45° field of view
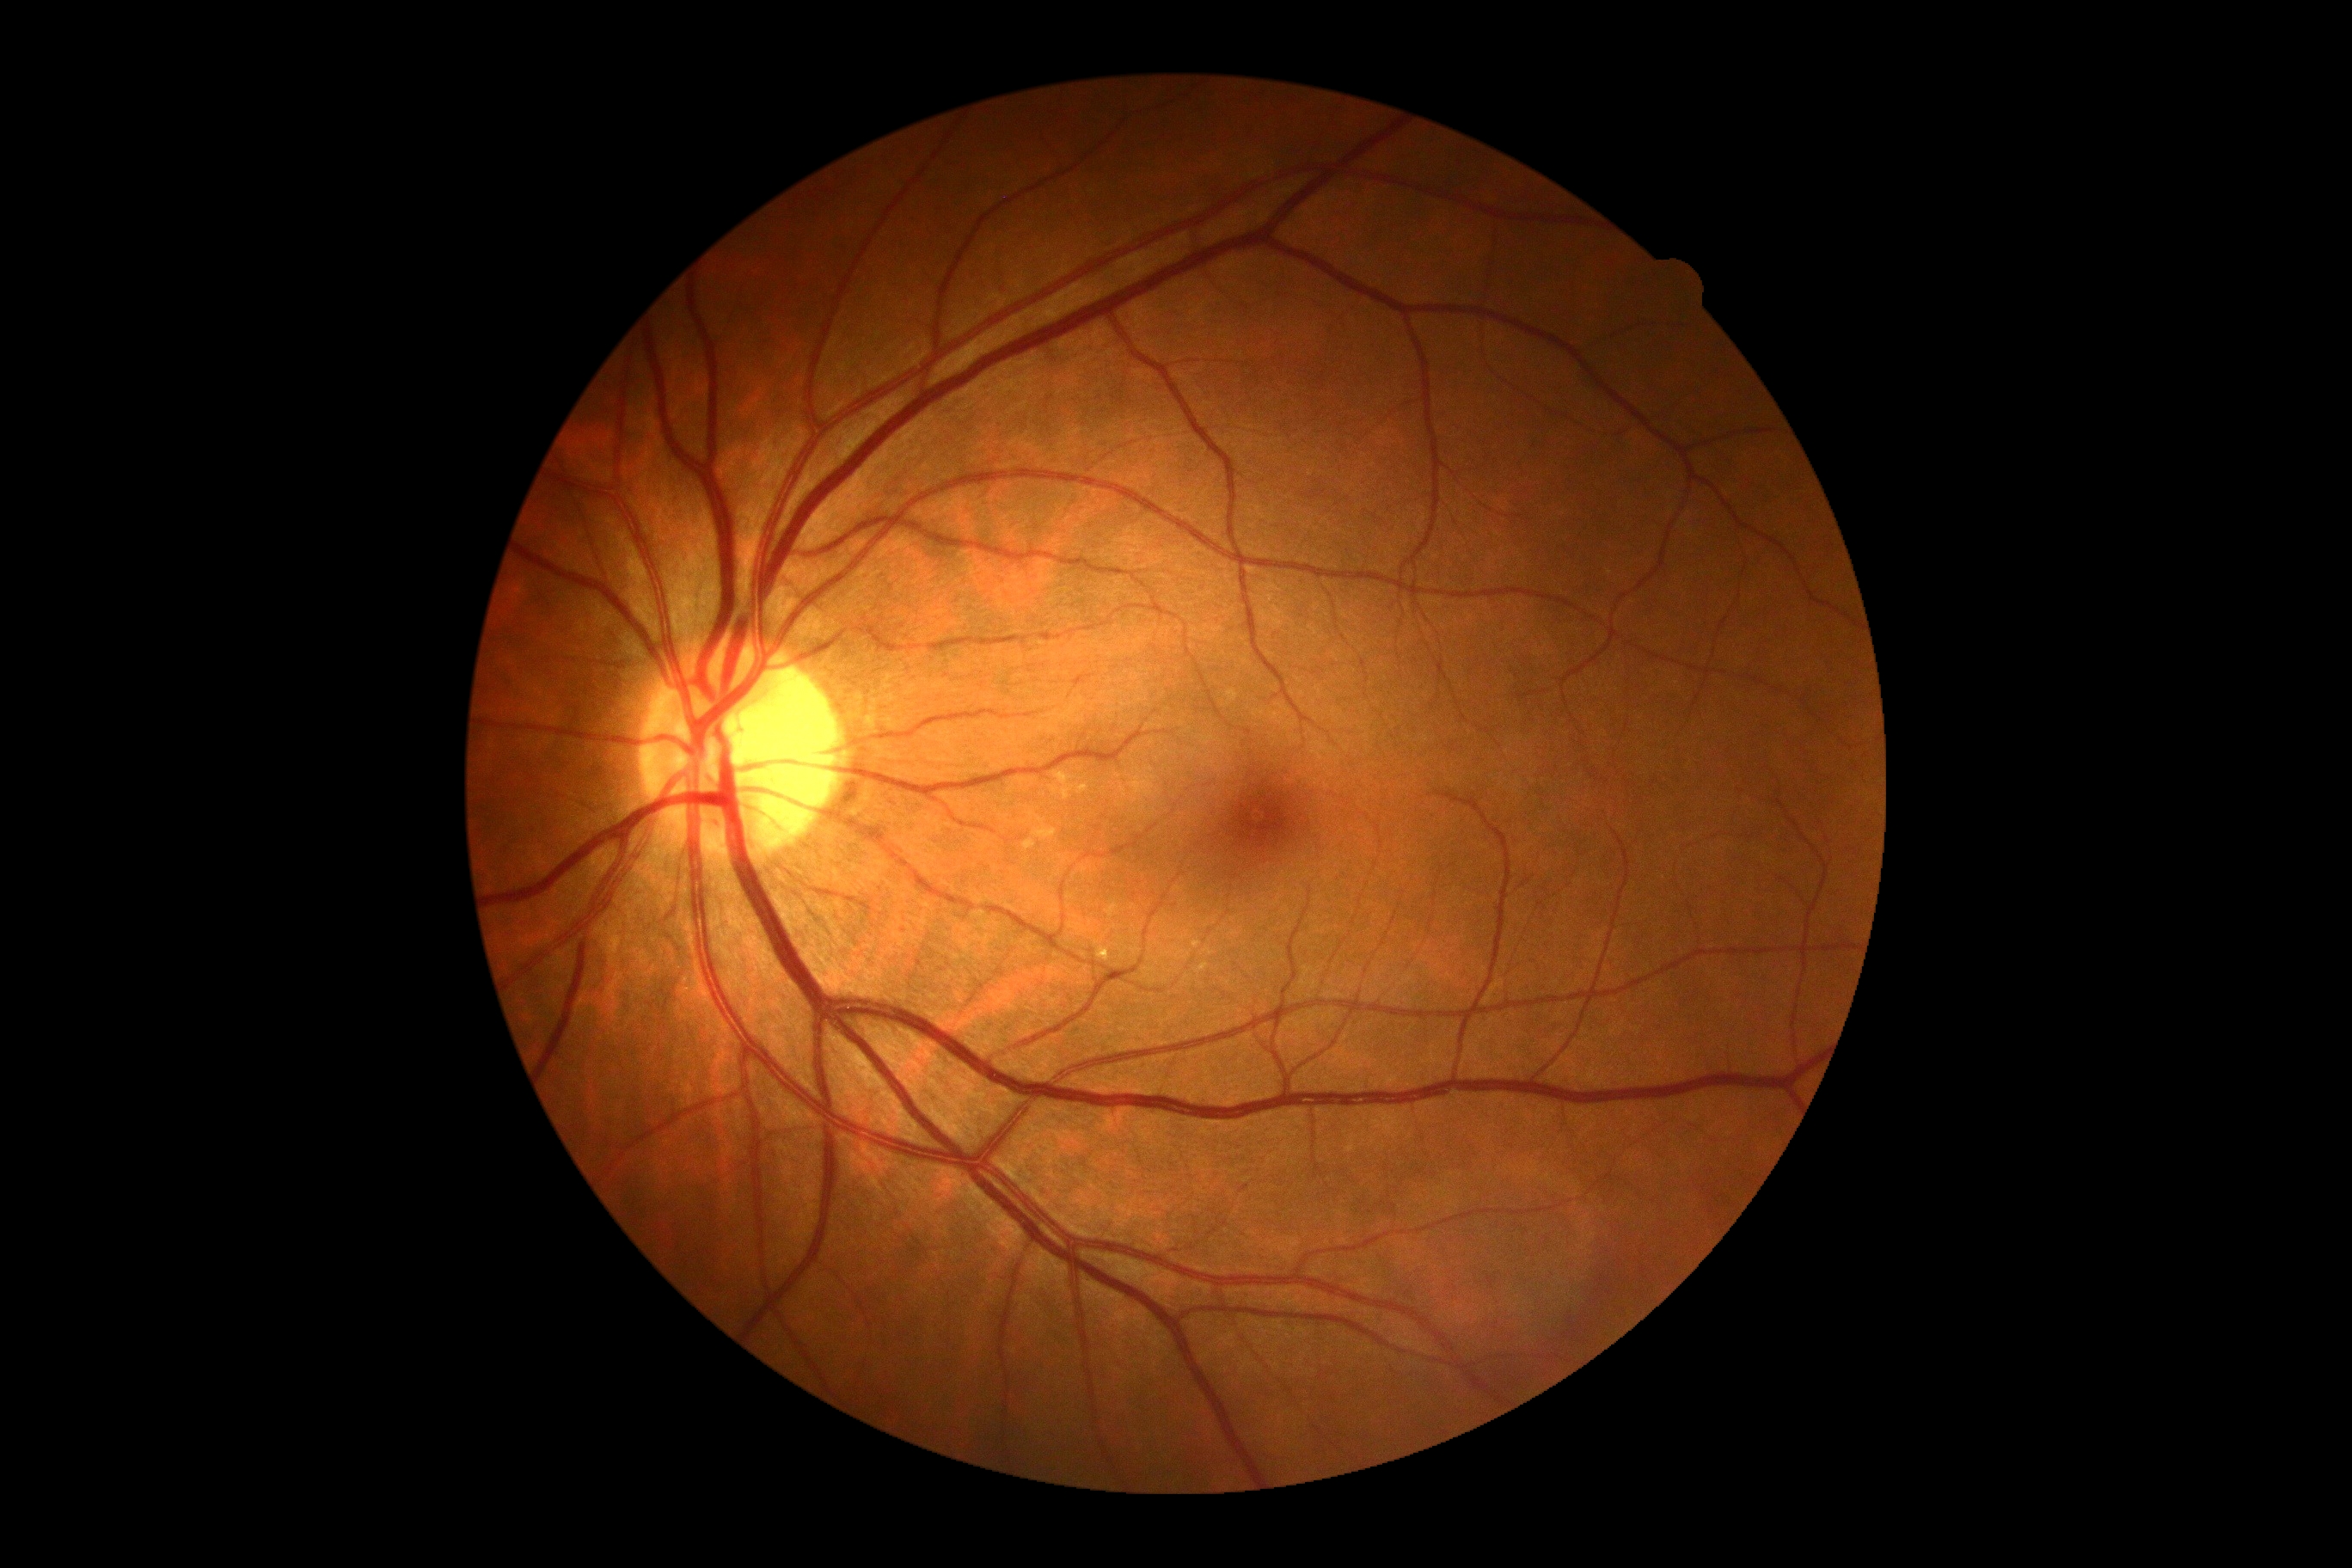 DR severity is grade 0 (no apparent retinopathy). No diabetic retinal disease findings.